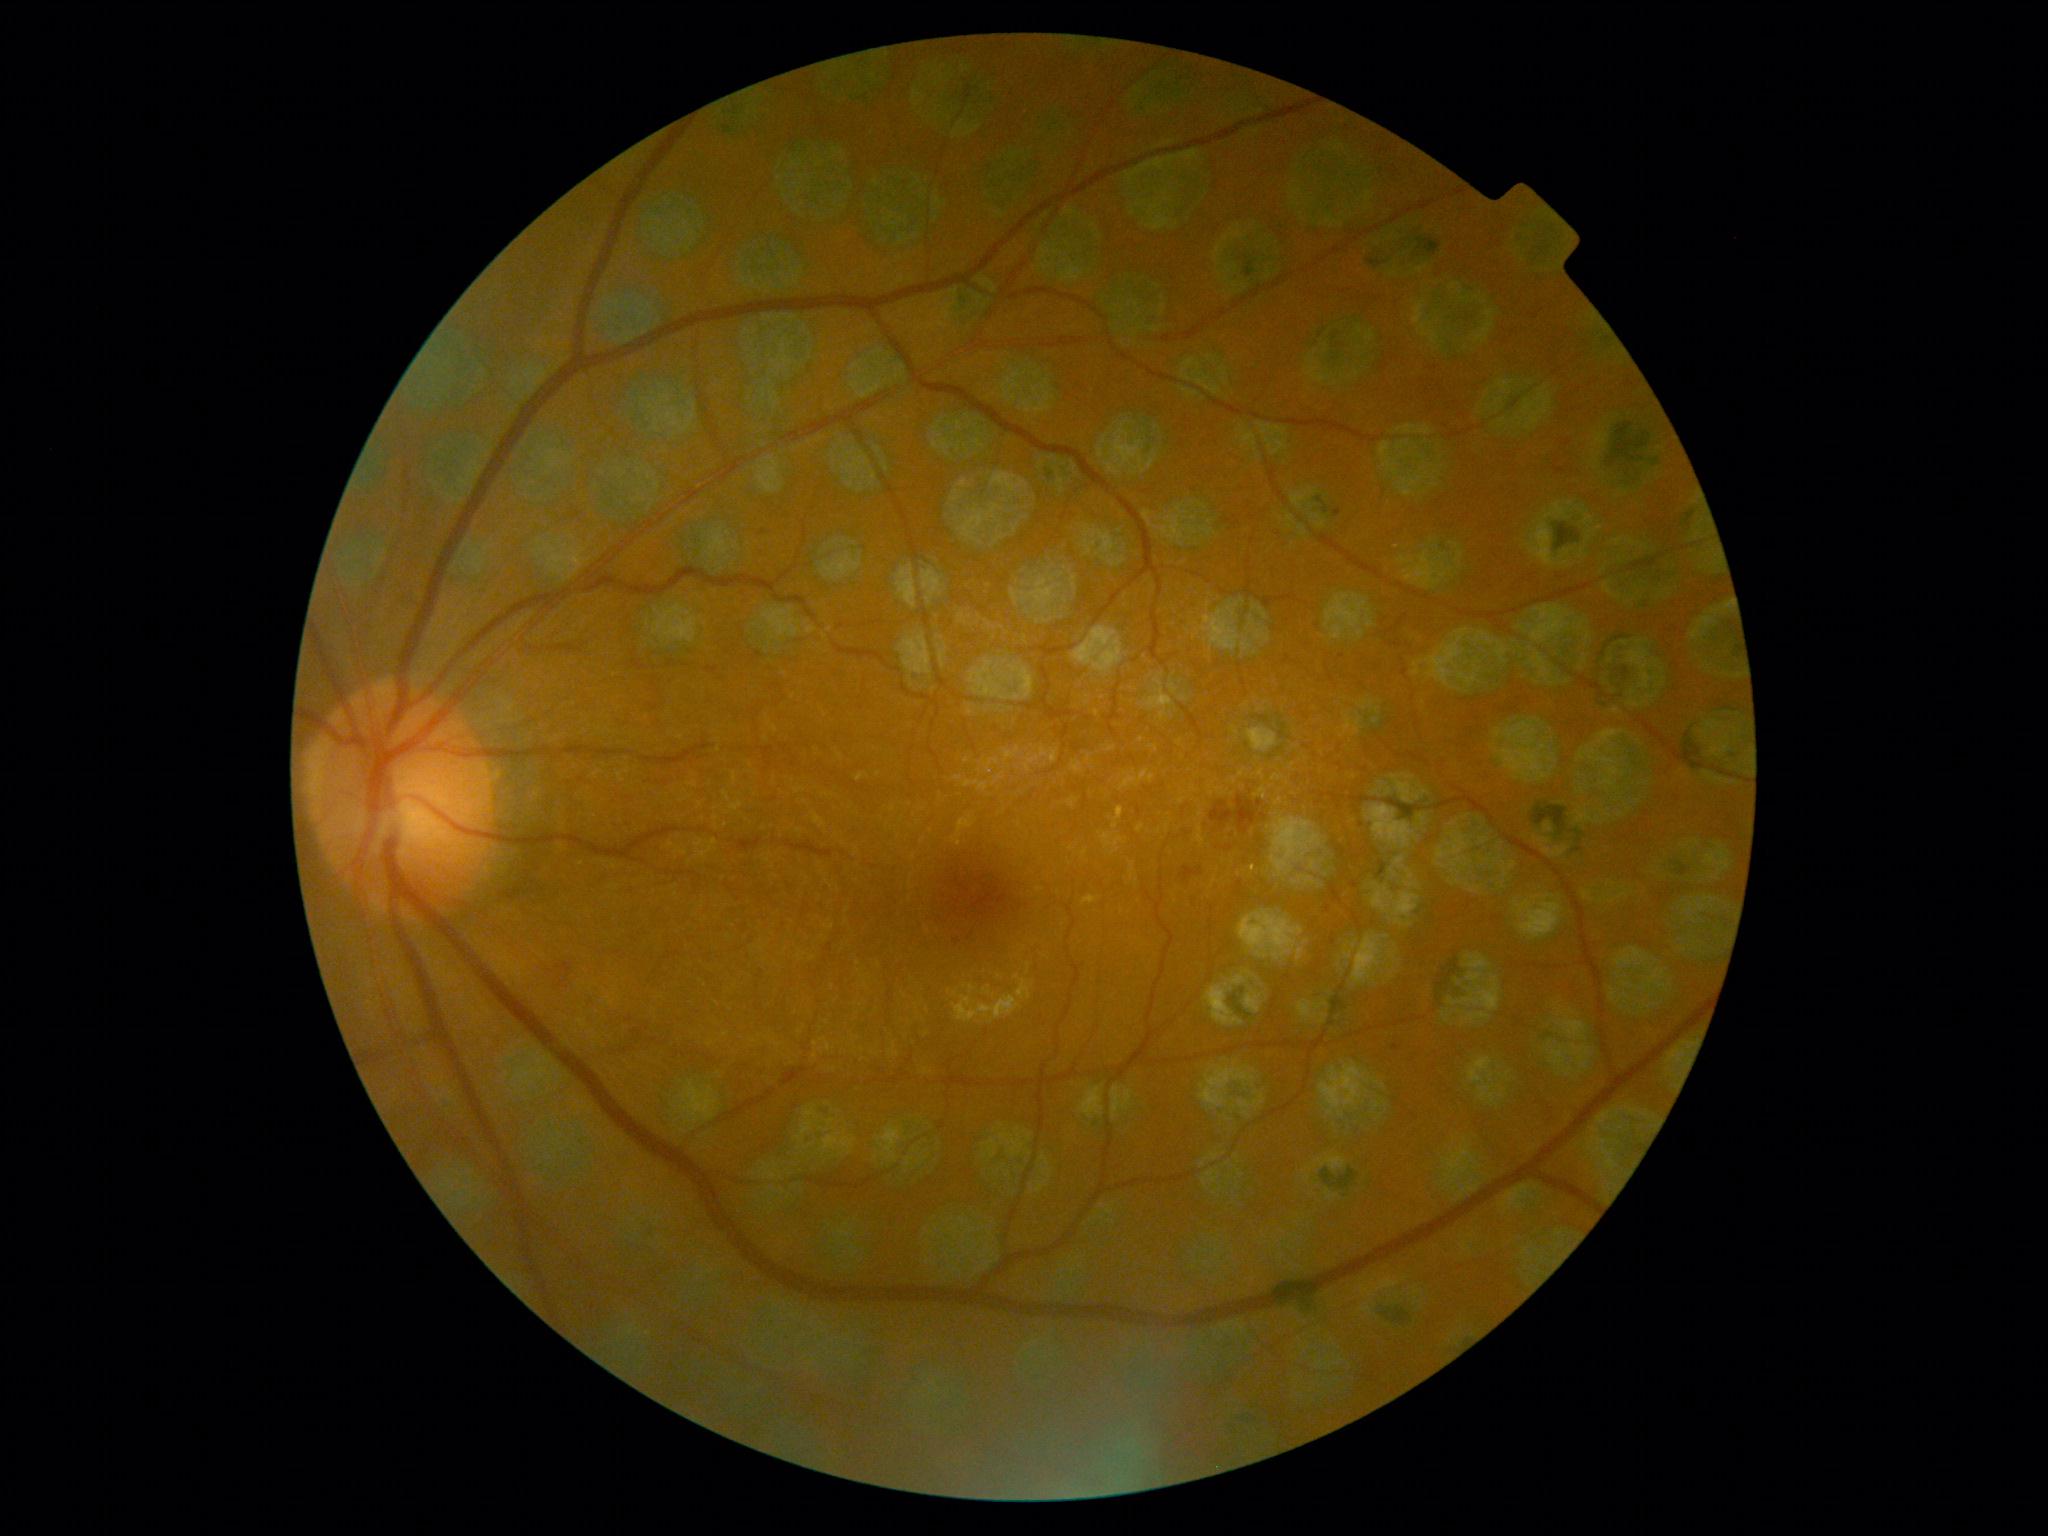

{"dr_grade": "2/4"}